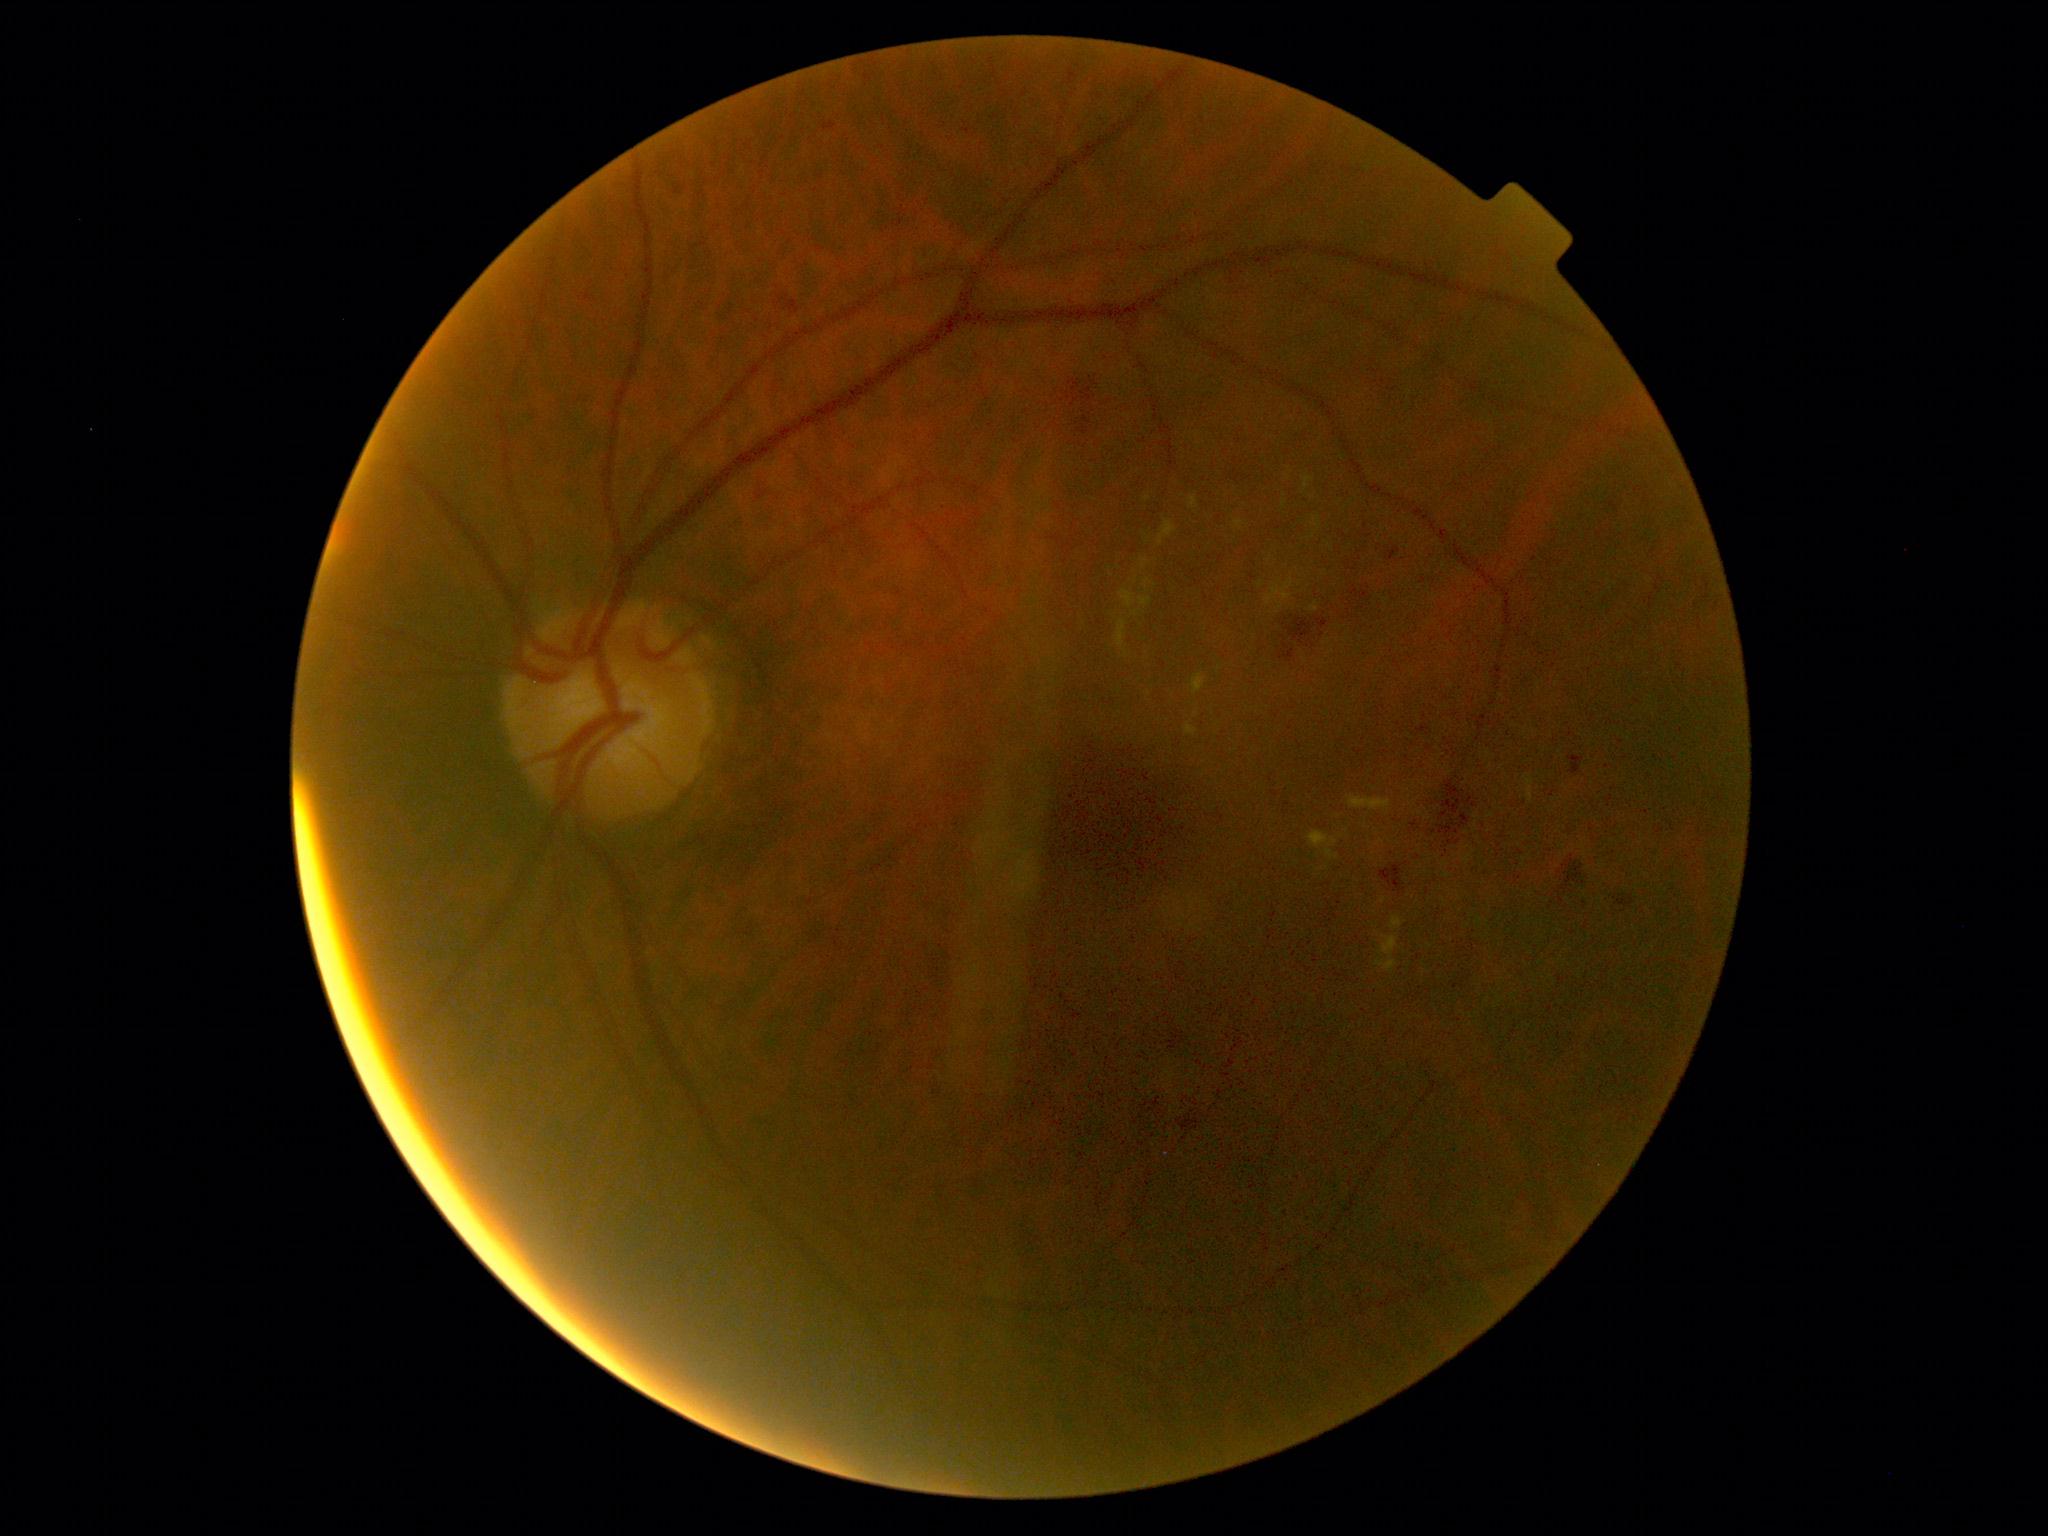

  dr_grade: 2 — more than just microaneurysms but less than severe NPDR